Pediatric retinal photograph (wide-field). Phoenix ICON, 100° FOV. 1240x1240px
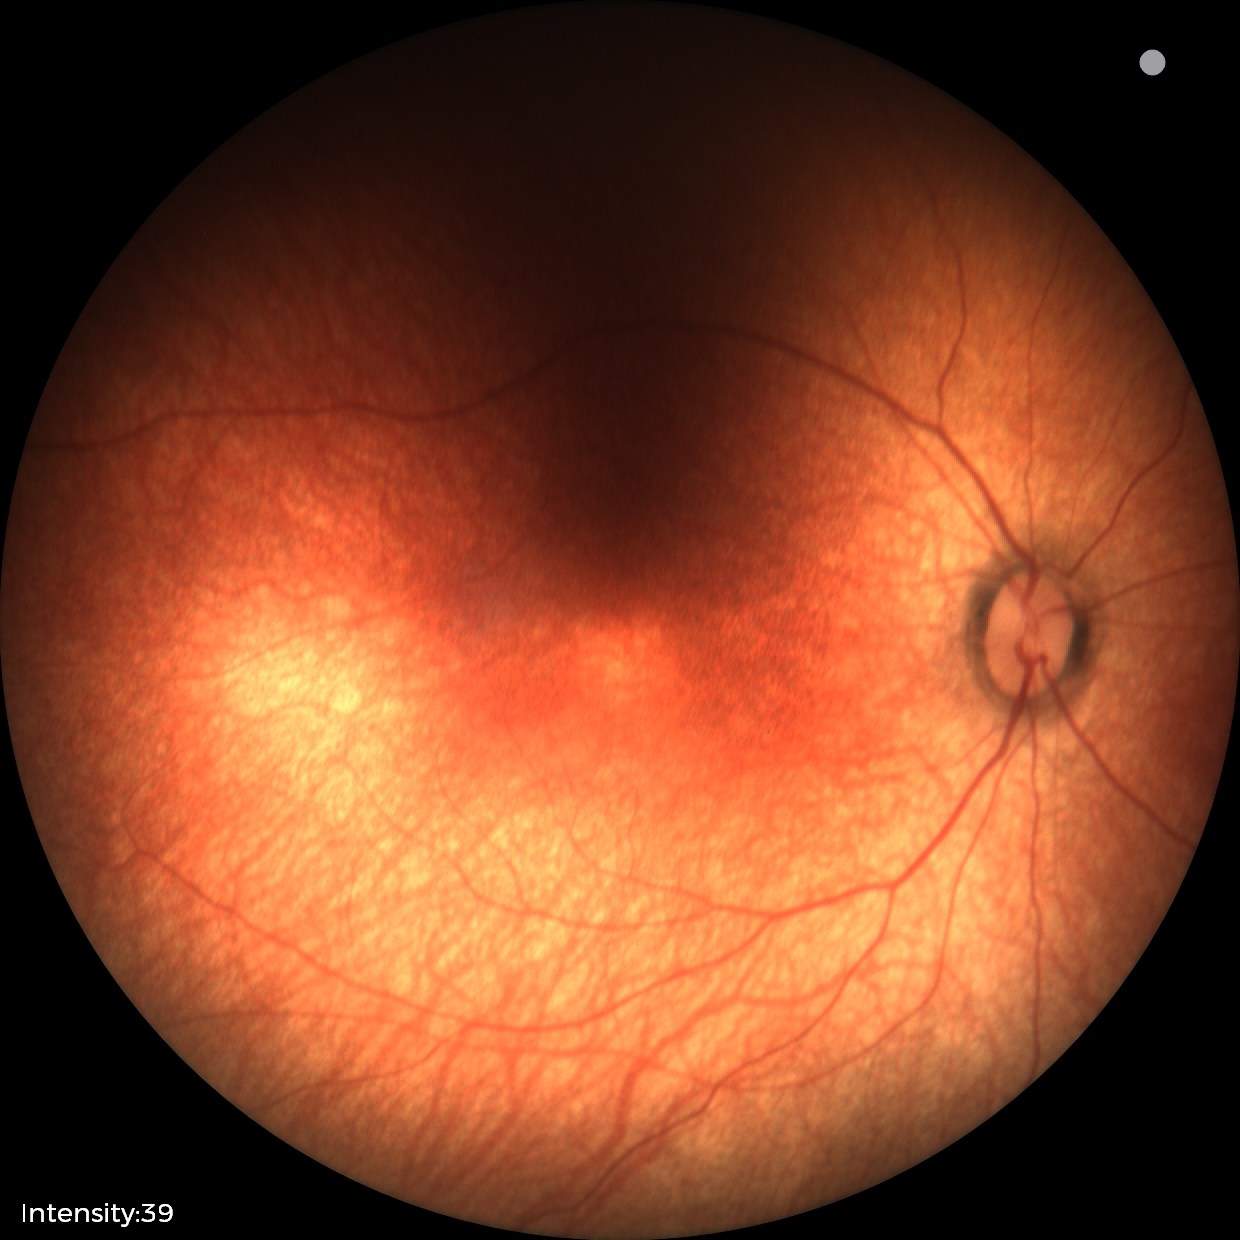
Physiological retinal appearance for postconceptual age.